45° field of view
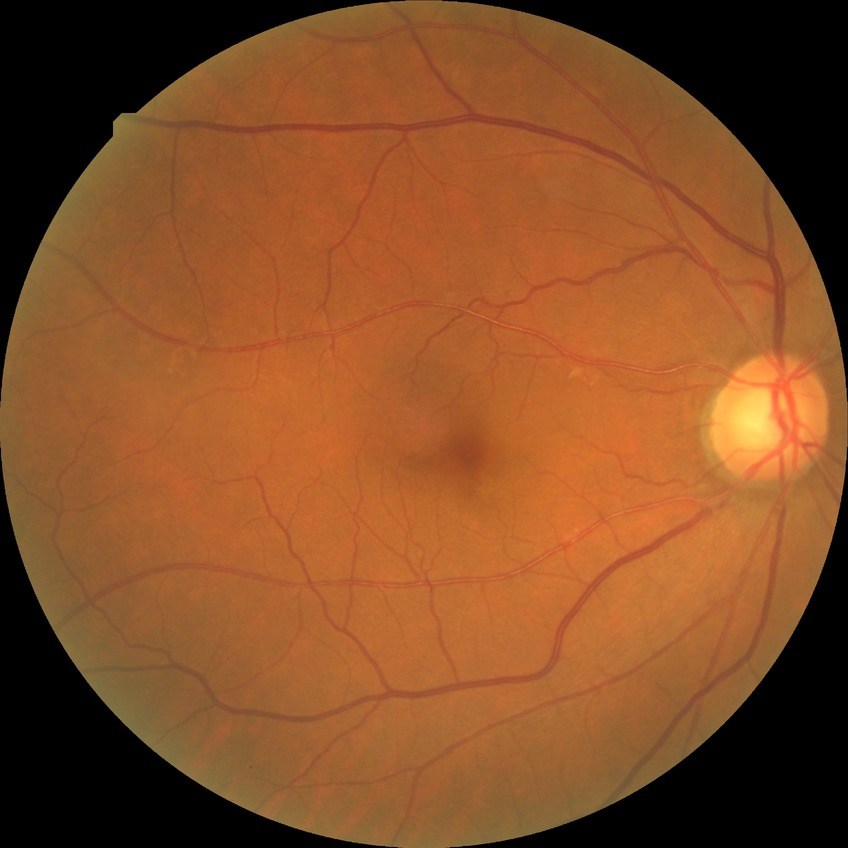
Findings:
- diabetic retinopathy grade — no diabetic retinopathy